Fundus photo · acquired with a NIDEK AFC-230 · without pupil dilation · graded on the modified Davis scale · 45-degree field of view:
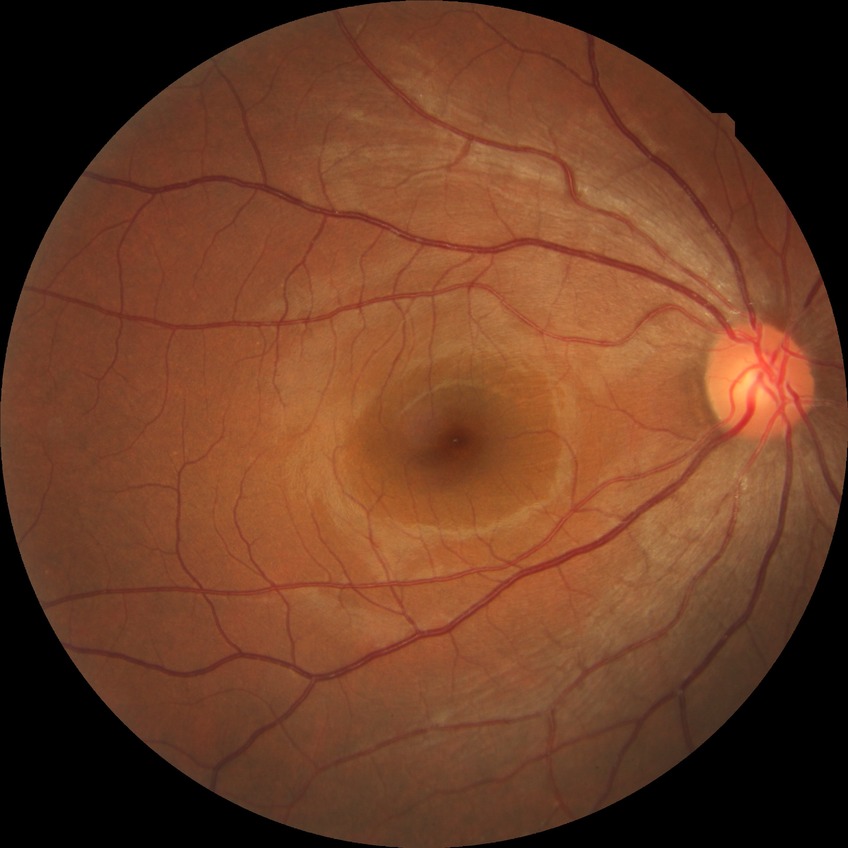 retinopathy stage=no diabetic retinopathy.